Wide-field contact fundus photograph of an infant: 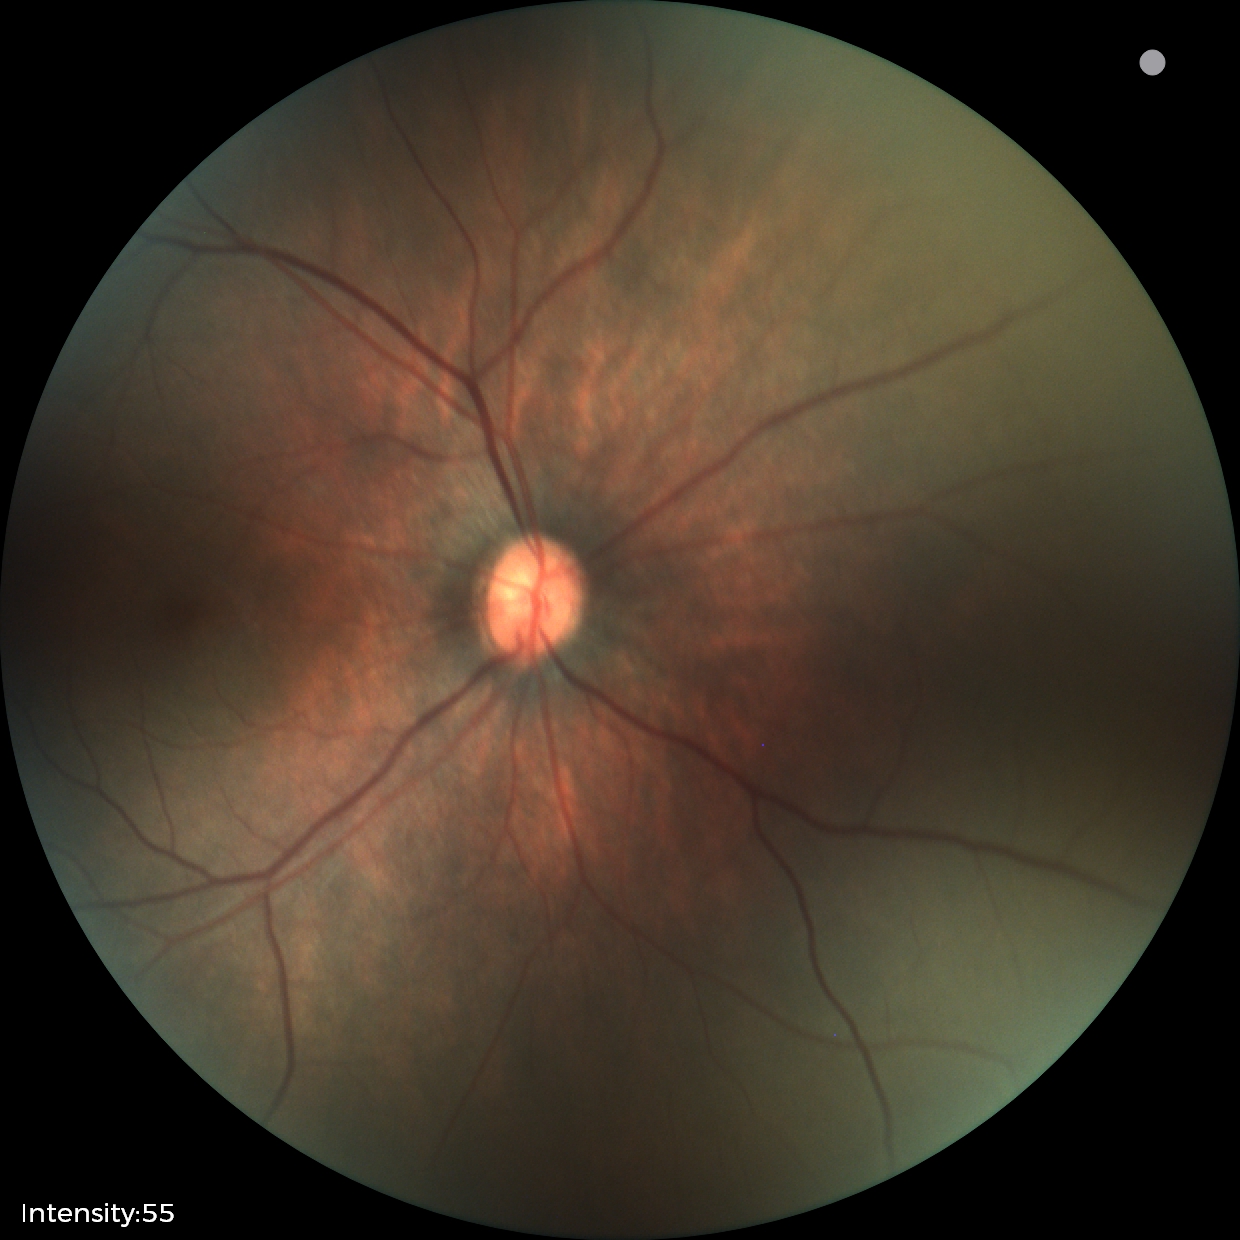 Normal screening examination.